Graded on the modified Davis scale; acquired with a NIDEK AFC-230; CFP; 848 by 848 pixels.
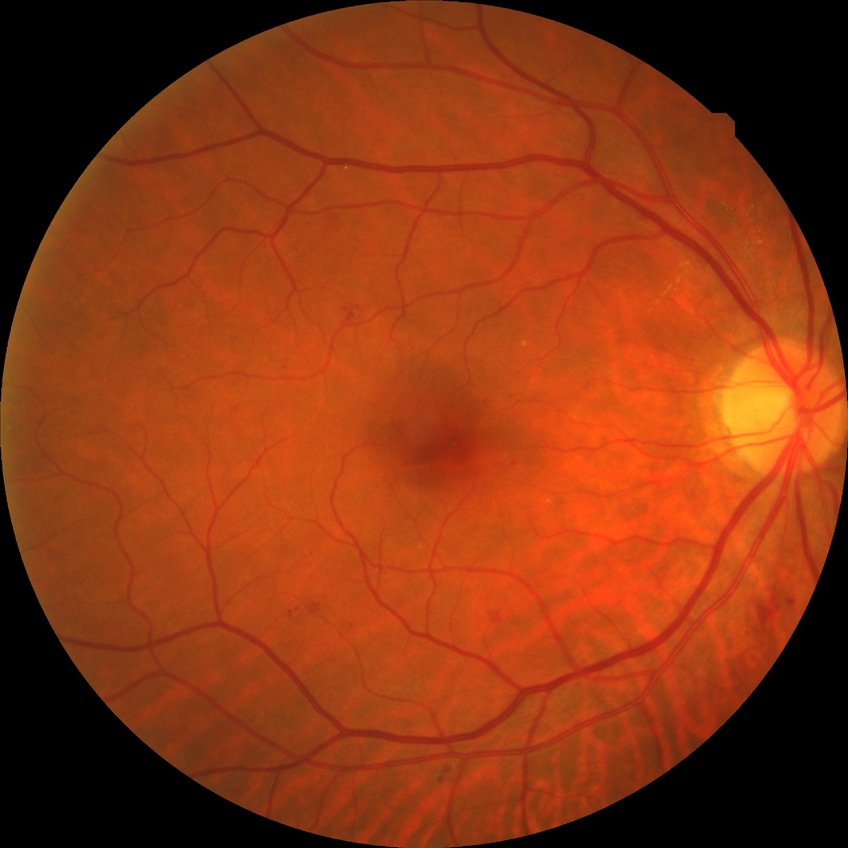
Diabetic retinopathy (DR): simple diabetic retinopathy (SDR).